Acquired on the Clarity RetCam 3 · infant wide-field fundus photograph — 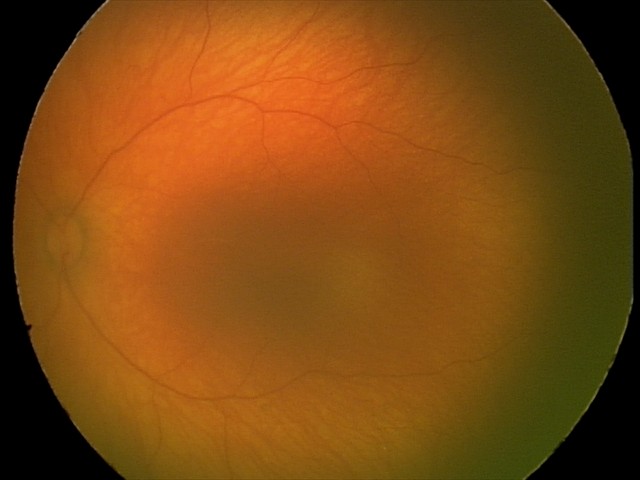 Screening examination with no abnormal retinal findings.